Image size 1380x1382: 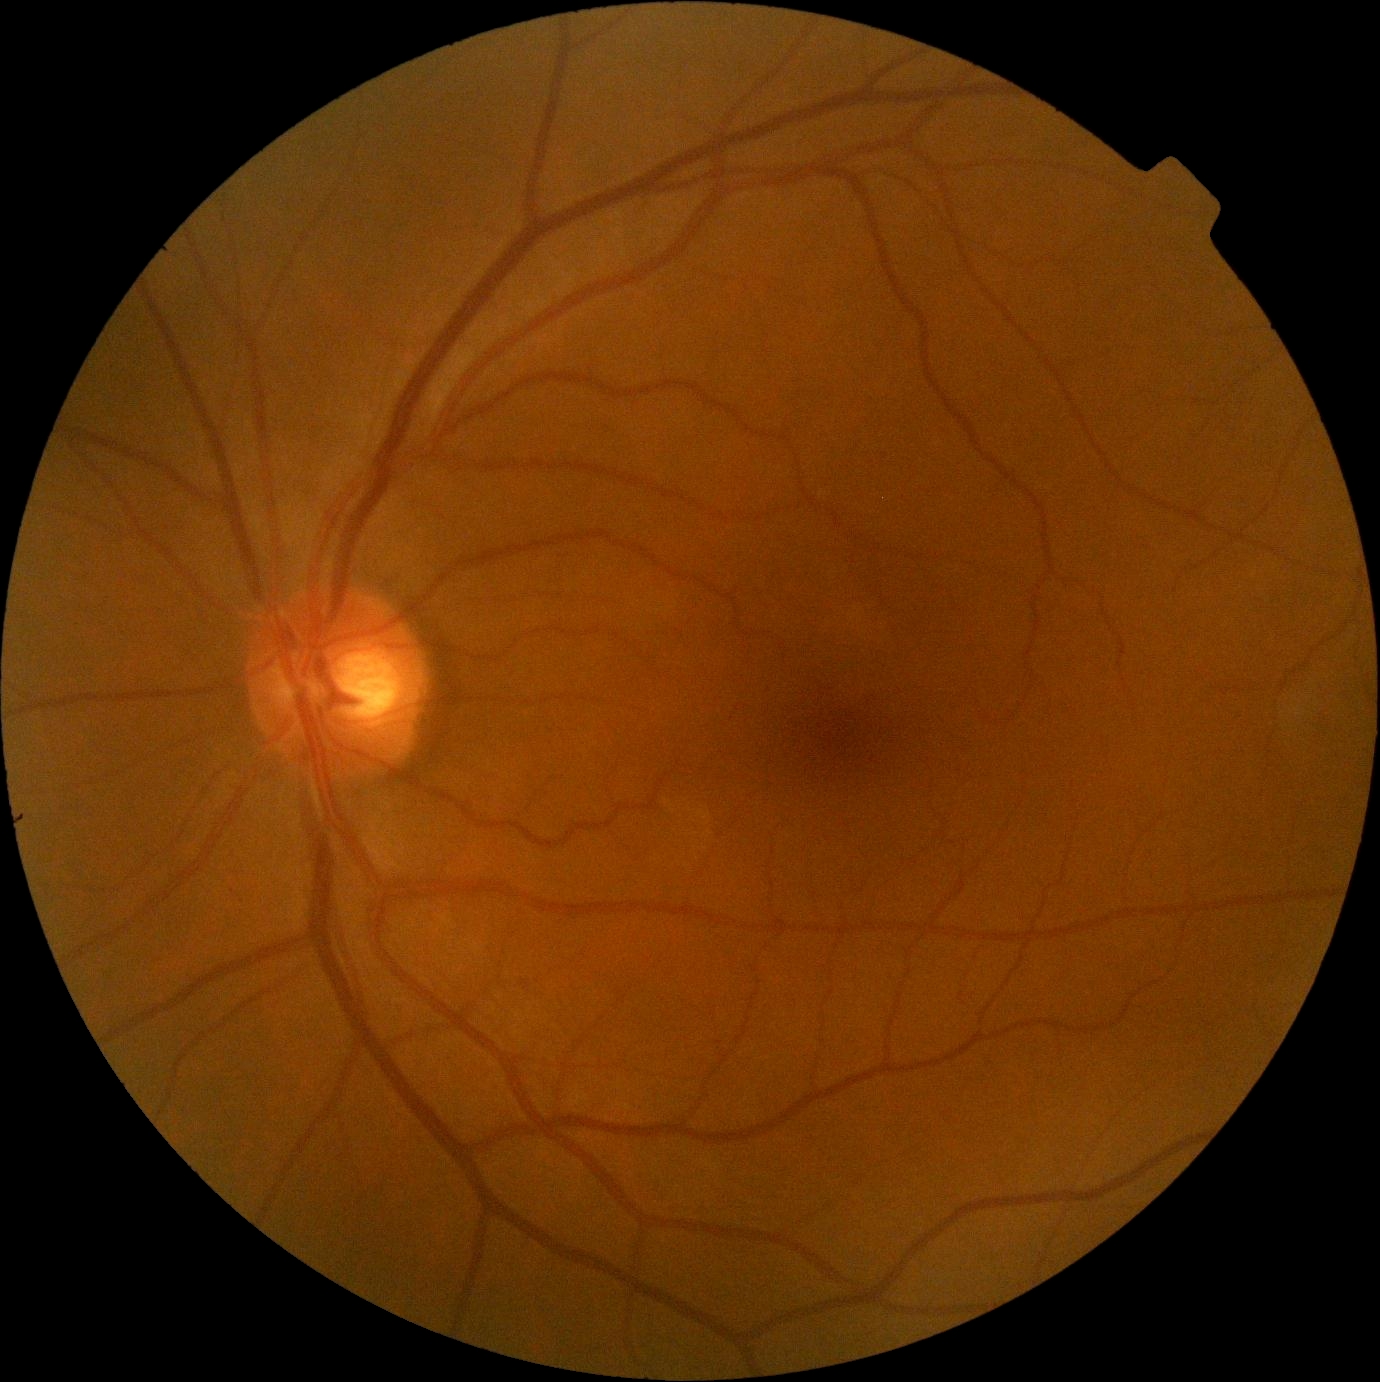 DR impression: no signs of DR, DR: no apparent retinopathy (grade 0).